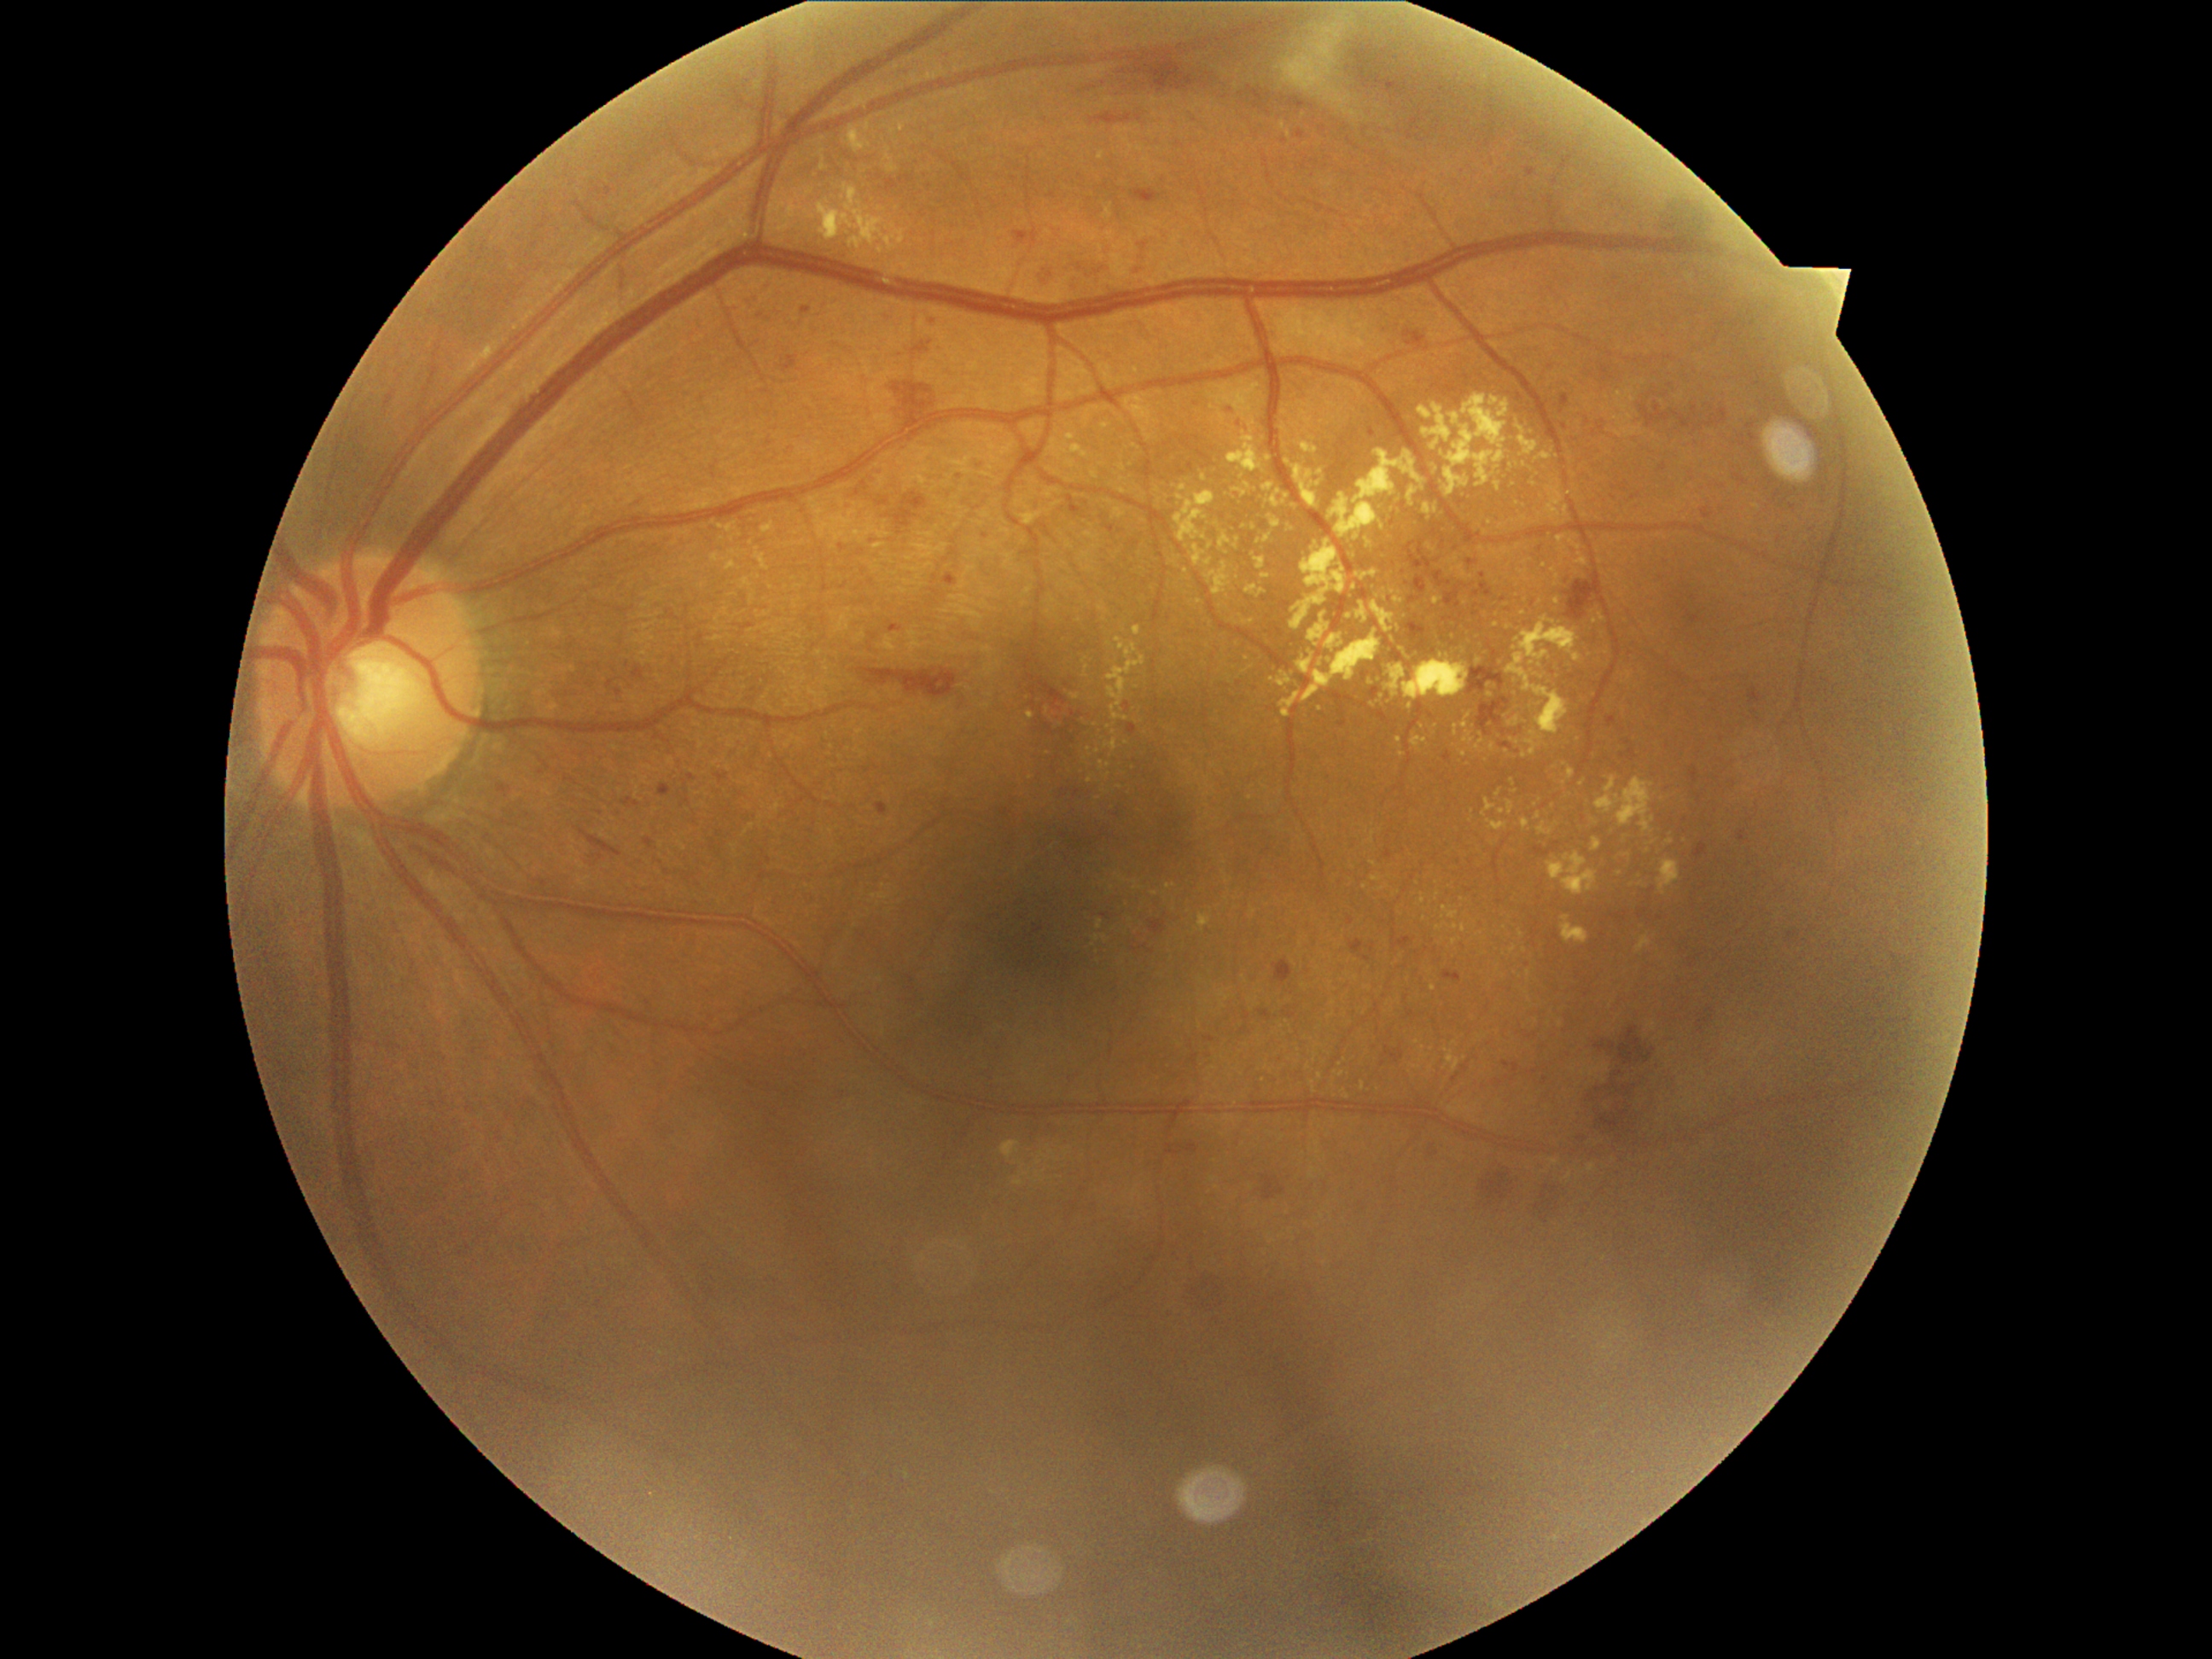
Diabetic retinopathy (DR): moderate NPDR (grade 2).
Hard exudates (EXs) include lesions at (x1=1448, y1=554, x2=1472, y2=581); (x1=1494, y1=482, x2=1503, y2=492); (x1=1597, y1=777, x2=1656, y2=834); (x1=1119, y1=489, x2=1129, y2=496); (x1=1356, y1=569, x2=1378, y2=579); (x1=1257, y1=535, x2=1272, y2=545); (x1=1419, y1=895, x2=1426, y2=904); (x1=1436, y1=924, x2=1448, y2=933); (x1=1301, y1=438, x2=1318, y2=455).
Smaller EXs around pt(1084, 660); pt(1290, 135); pt(1544, 566); pt(1499, 794); pt(1124, 480); pt(1502, 812); pt(1392, 593); pt(1748, 790); pt(1501, 526); pt(1331, 1015).